Camera: Phoenix ICON (100° FOV); 1240x1240px; wide-field fundus photograph from neonatal ROP screening.
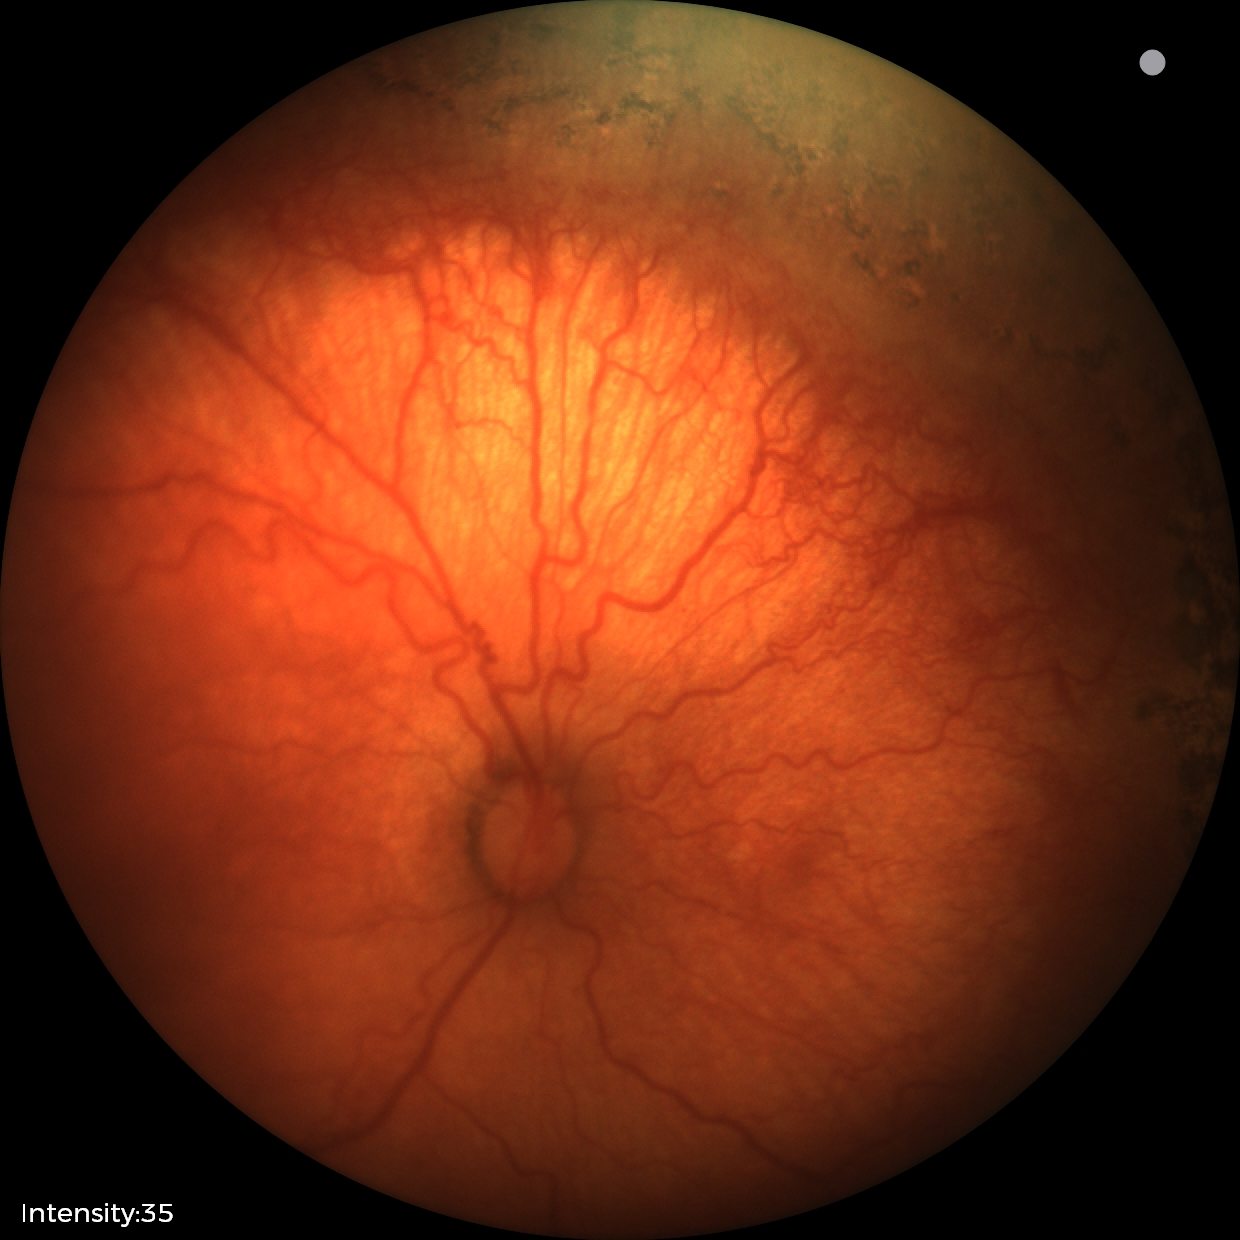

Screening: retinopathy of prematurity stage 1 | plus disease.